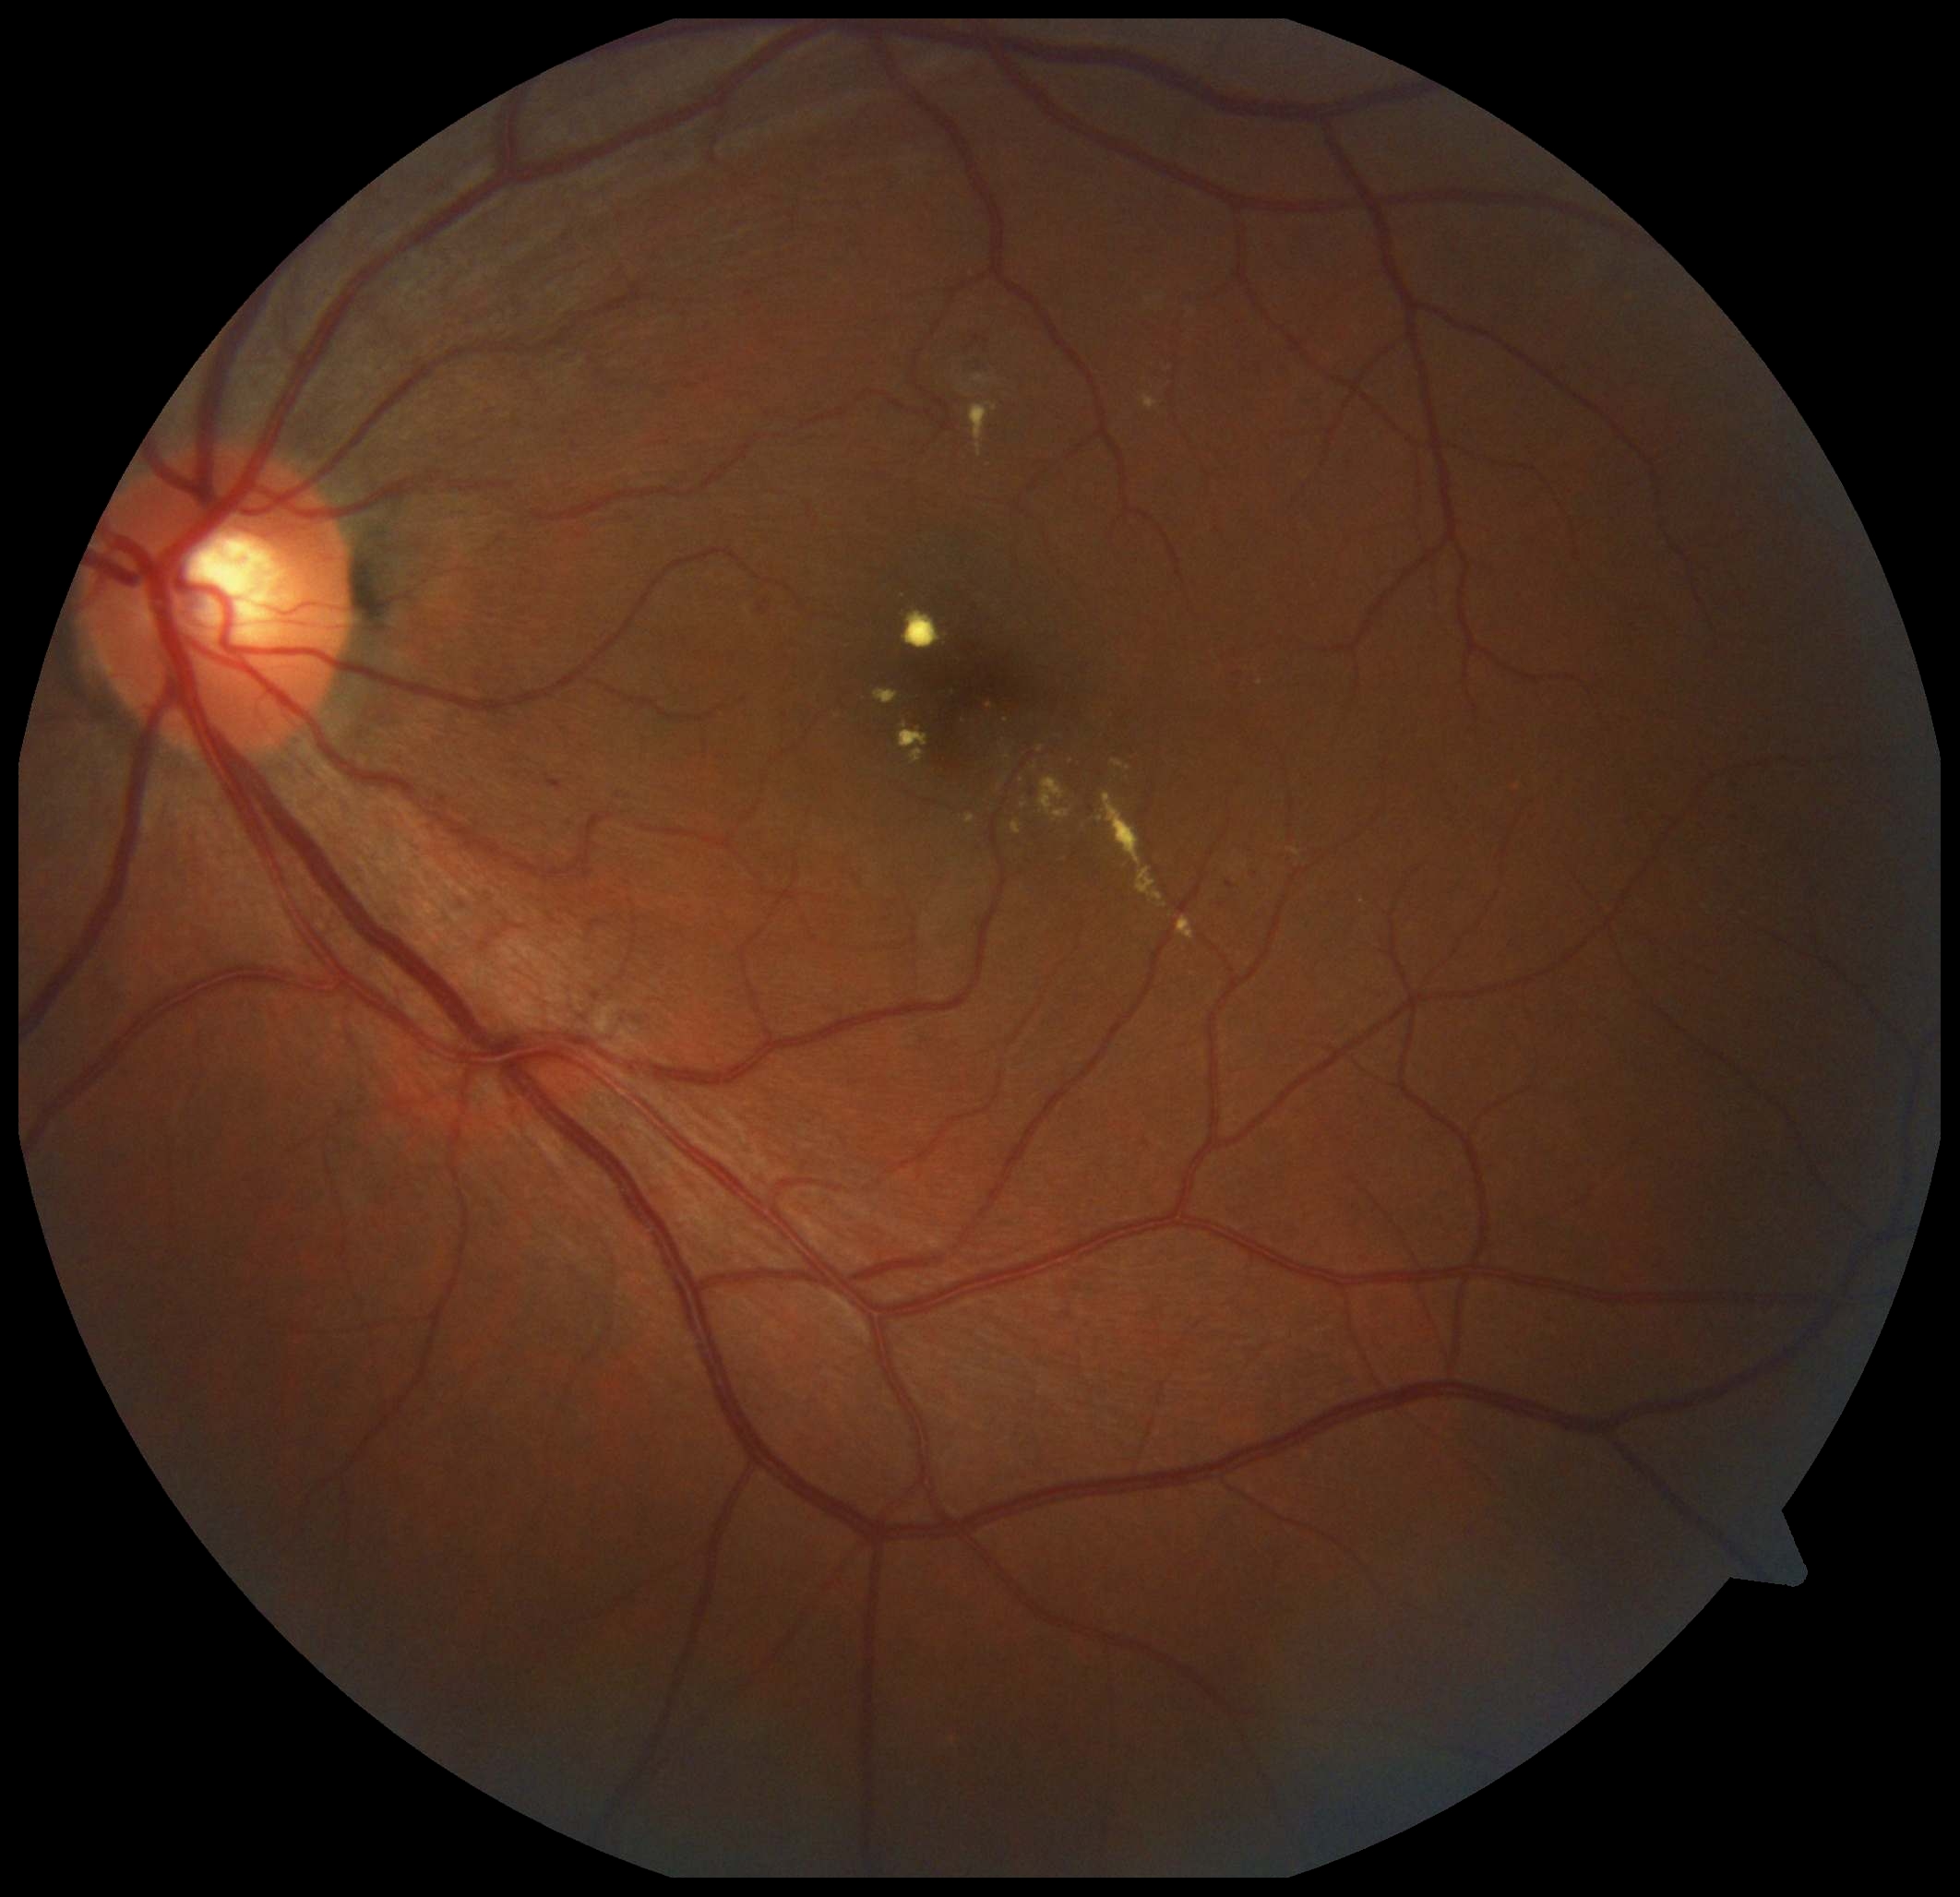 Diabetic retinopathy (DR) is moderate NPDR (grade 2).